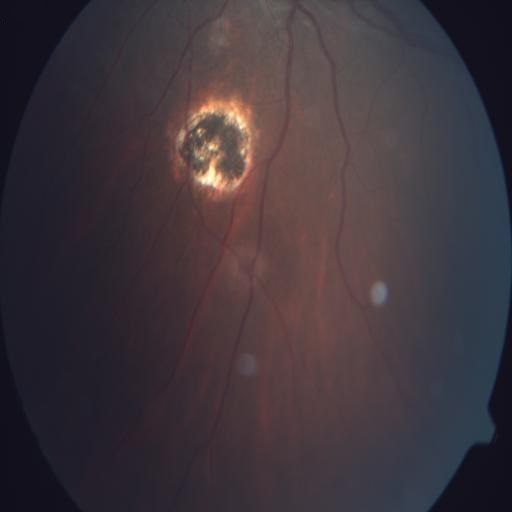
Showing CRS (chorioretinitis).